45° FOV:
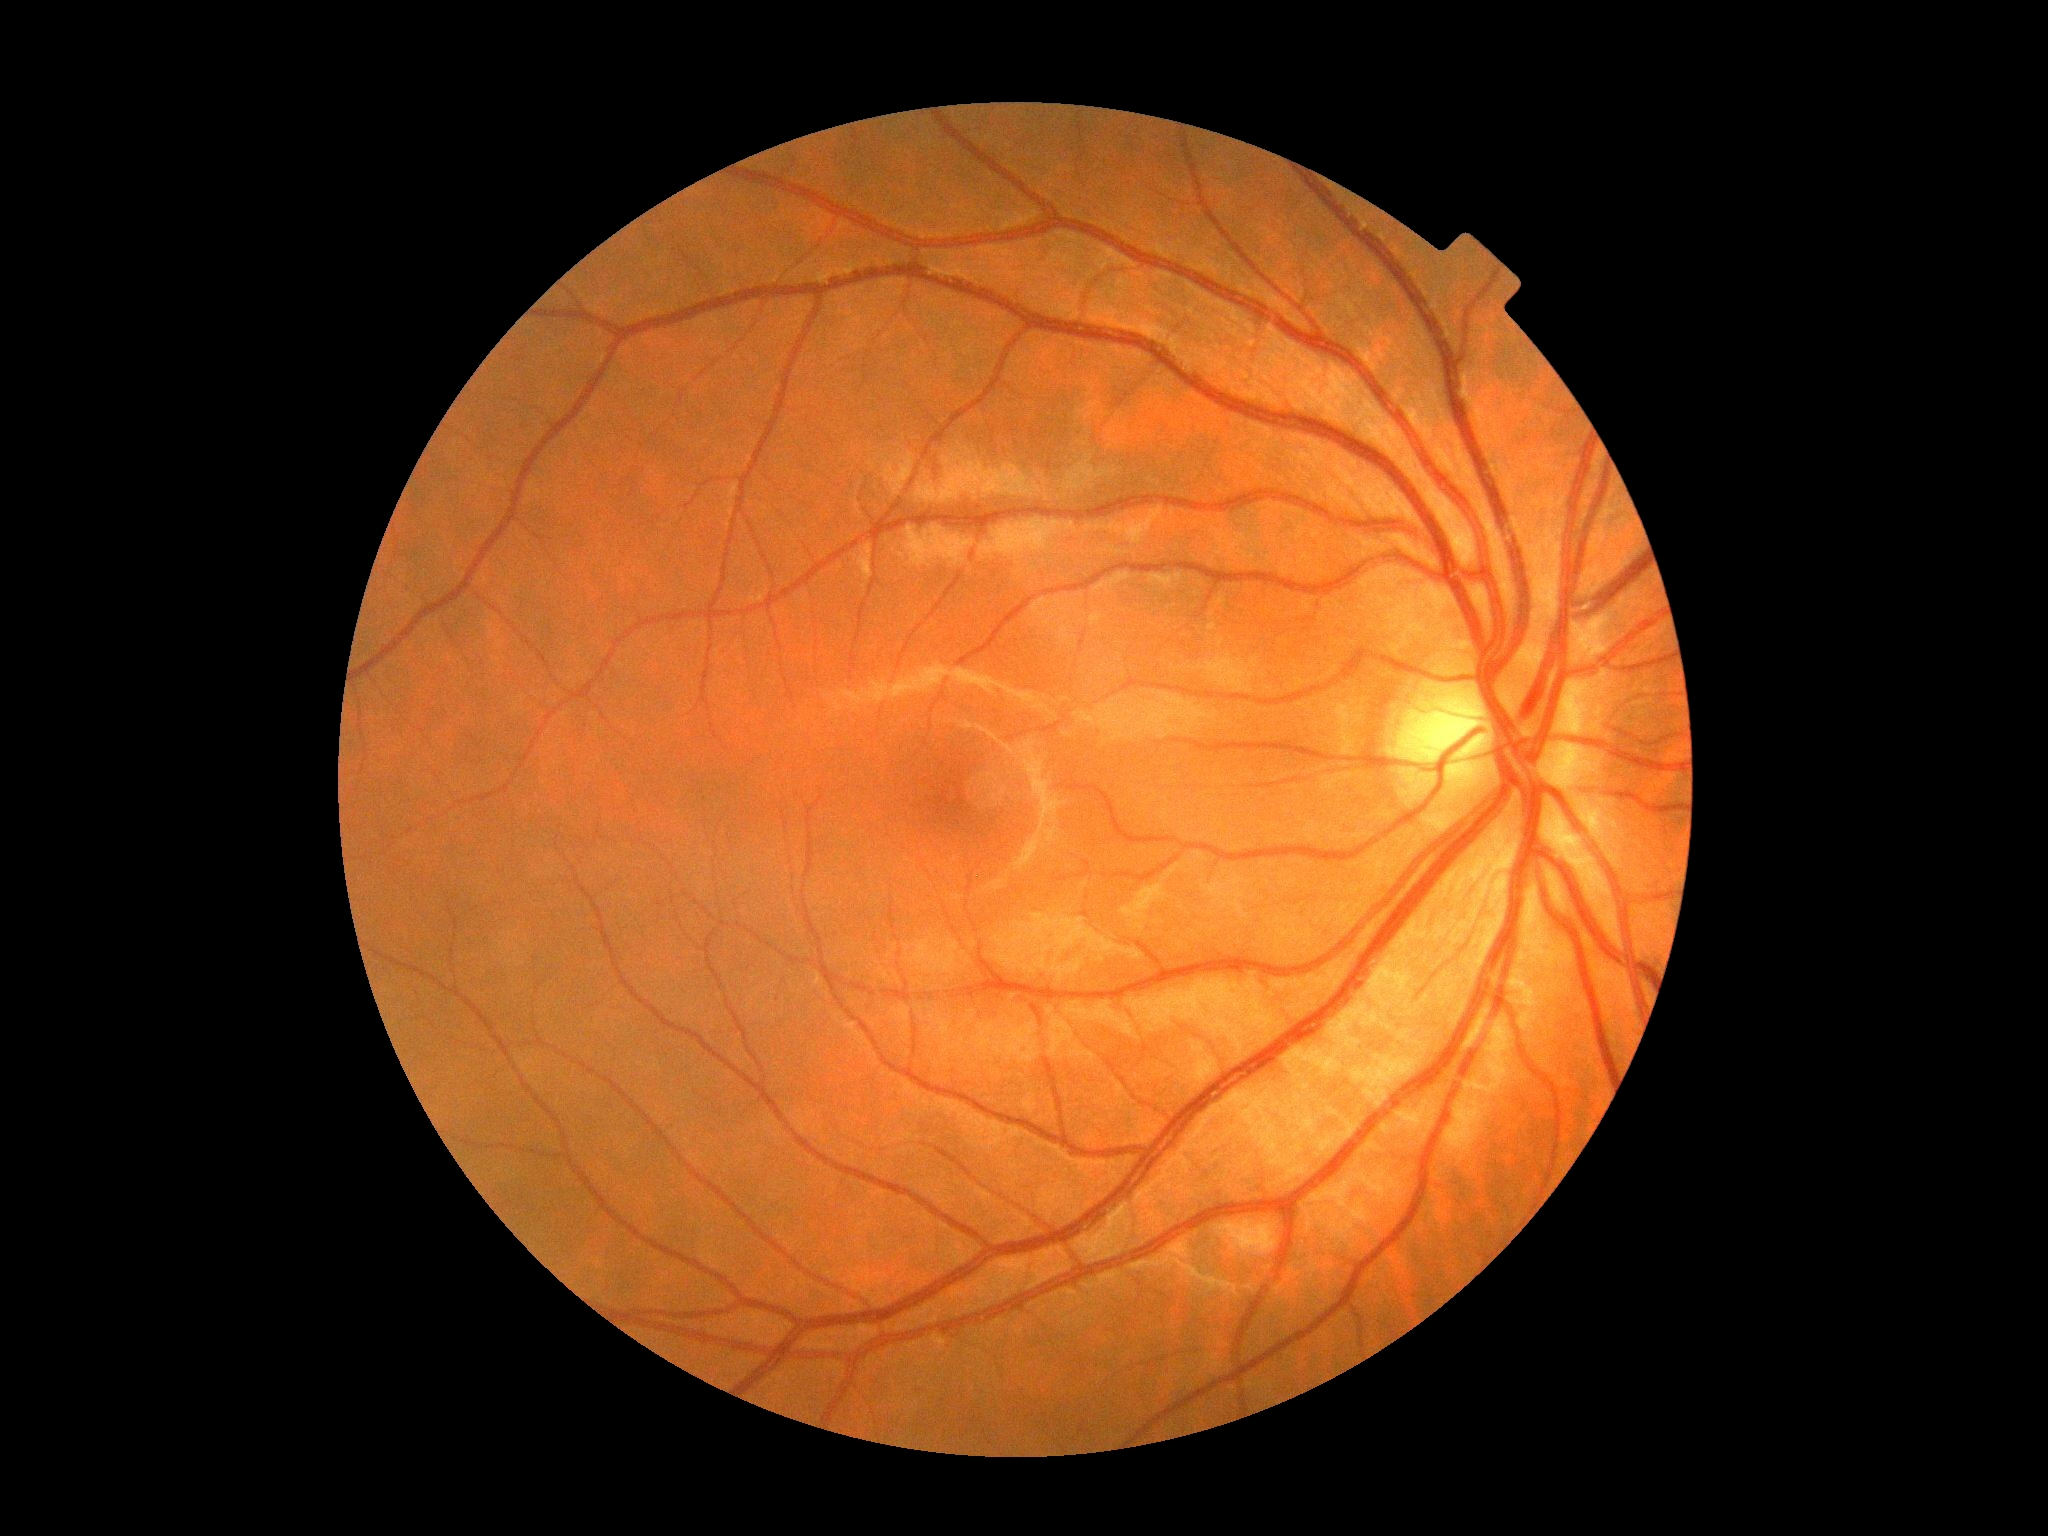
Diabetic retinopathy is no apparent diabetic retinopathy (grade 0).